130° field of view (Natus RetCam Envision) · 1440x1080px · infant wide-field retinal image
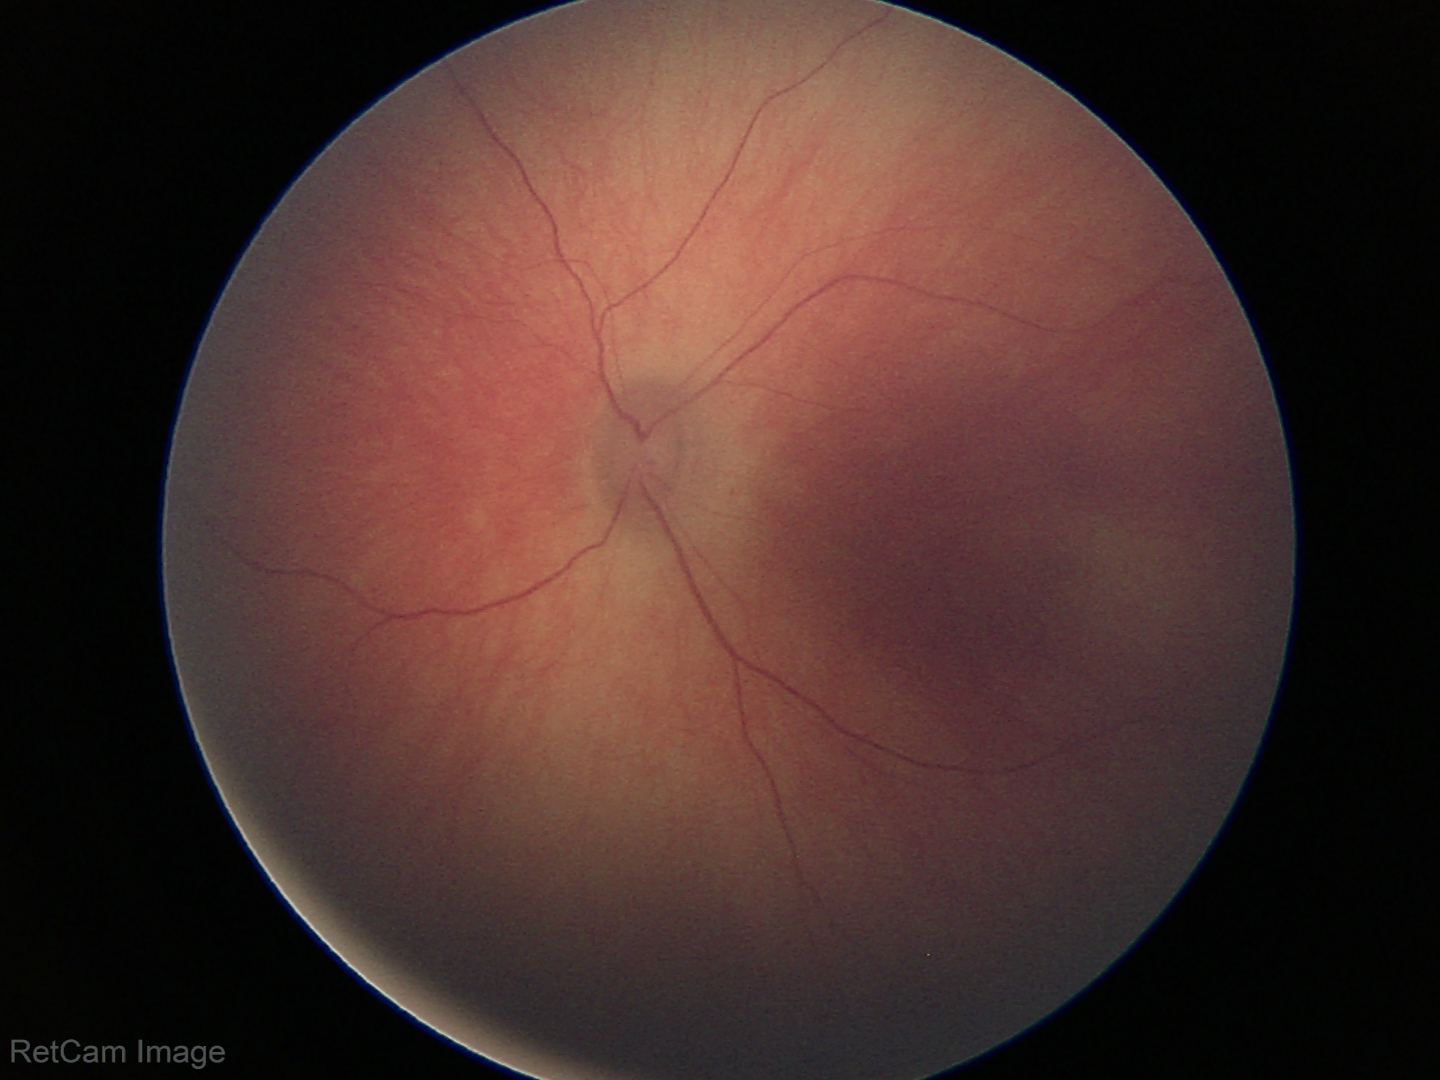
Screening examination with no abnormal retinal findings.